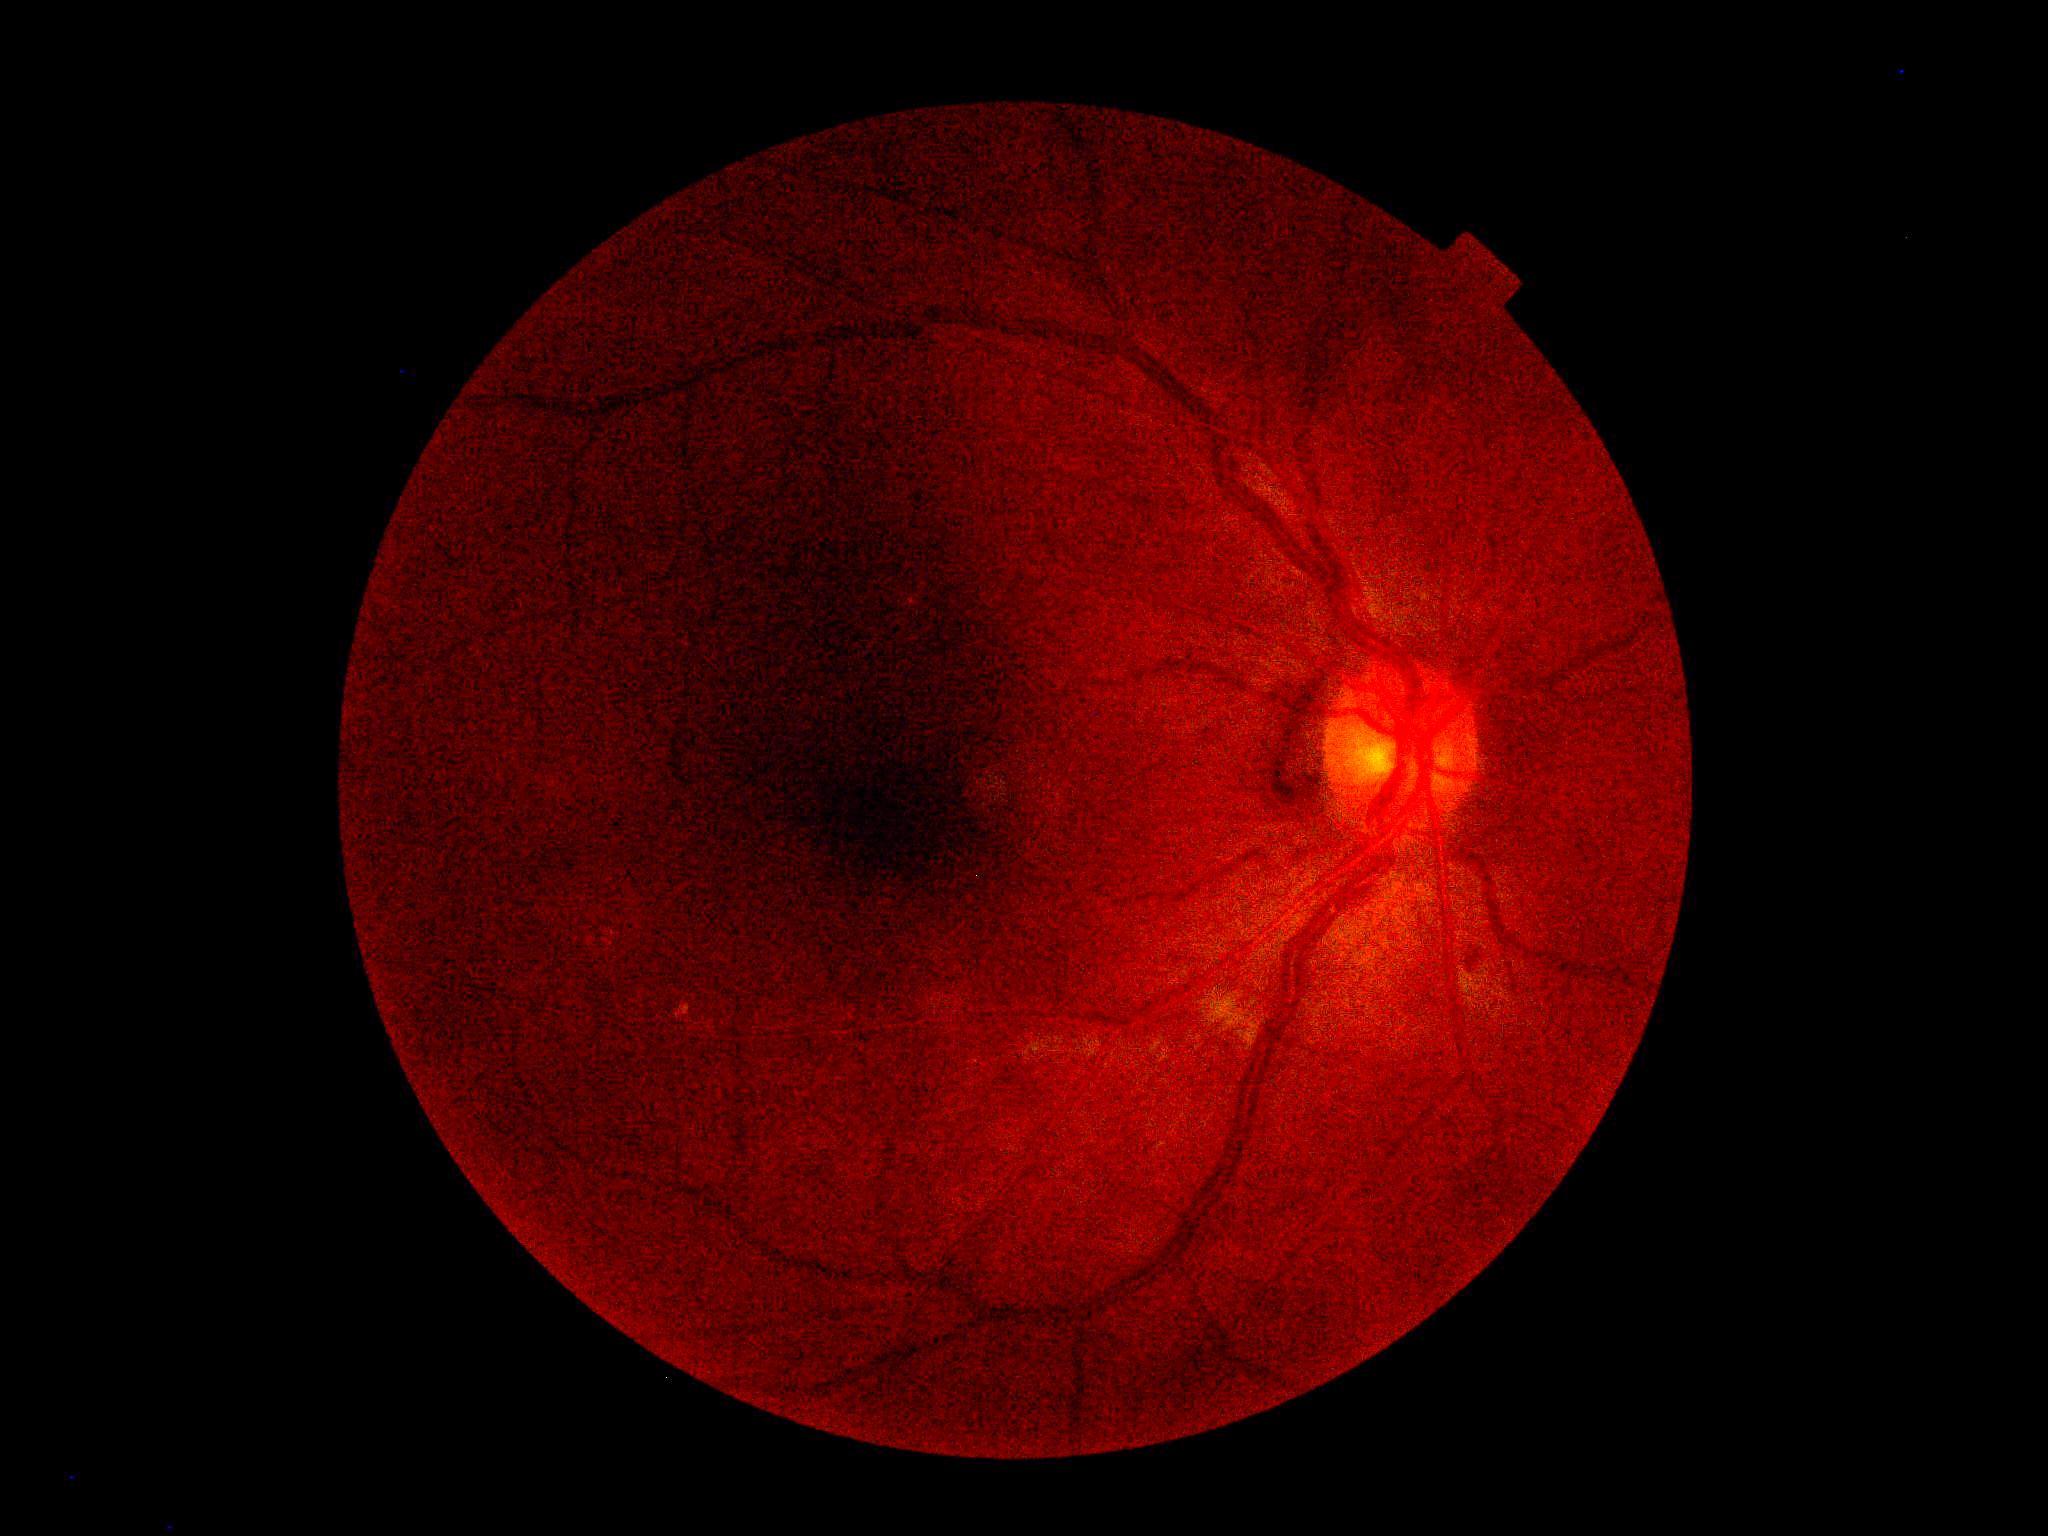
  dr_grade: ungradable
  quality: insufficient for DR assessment